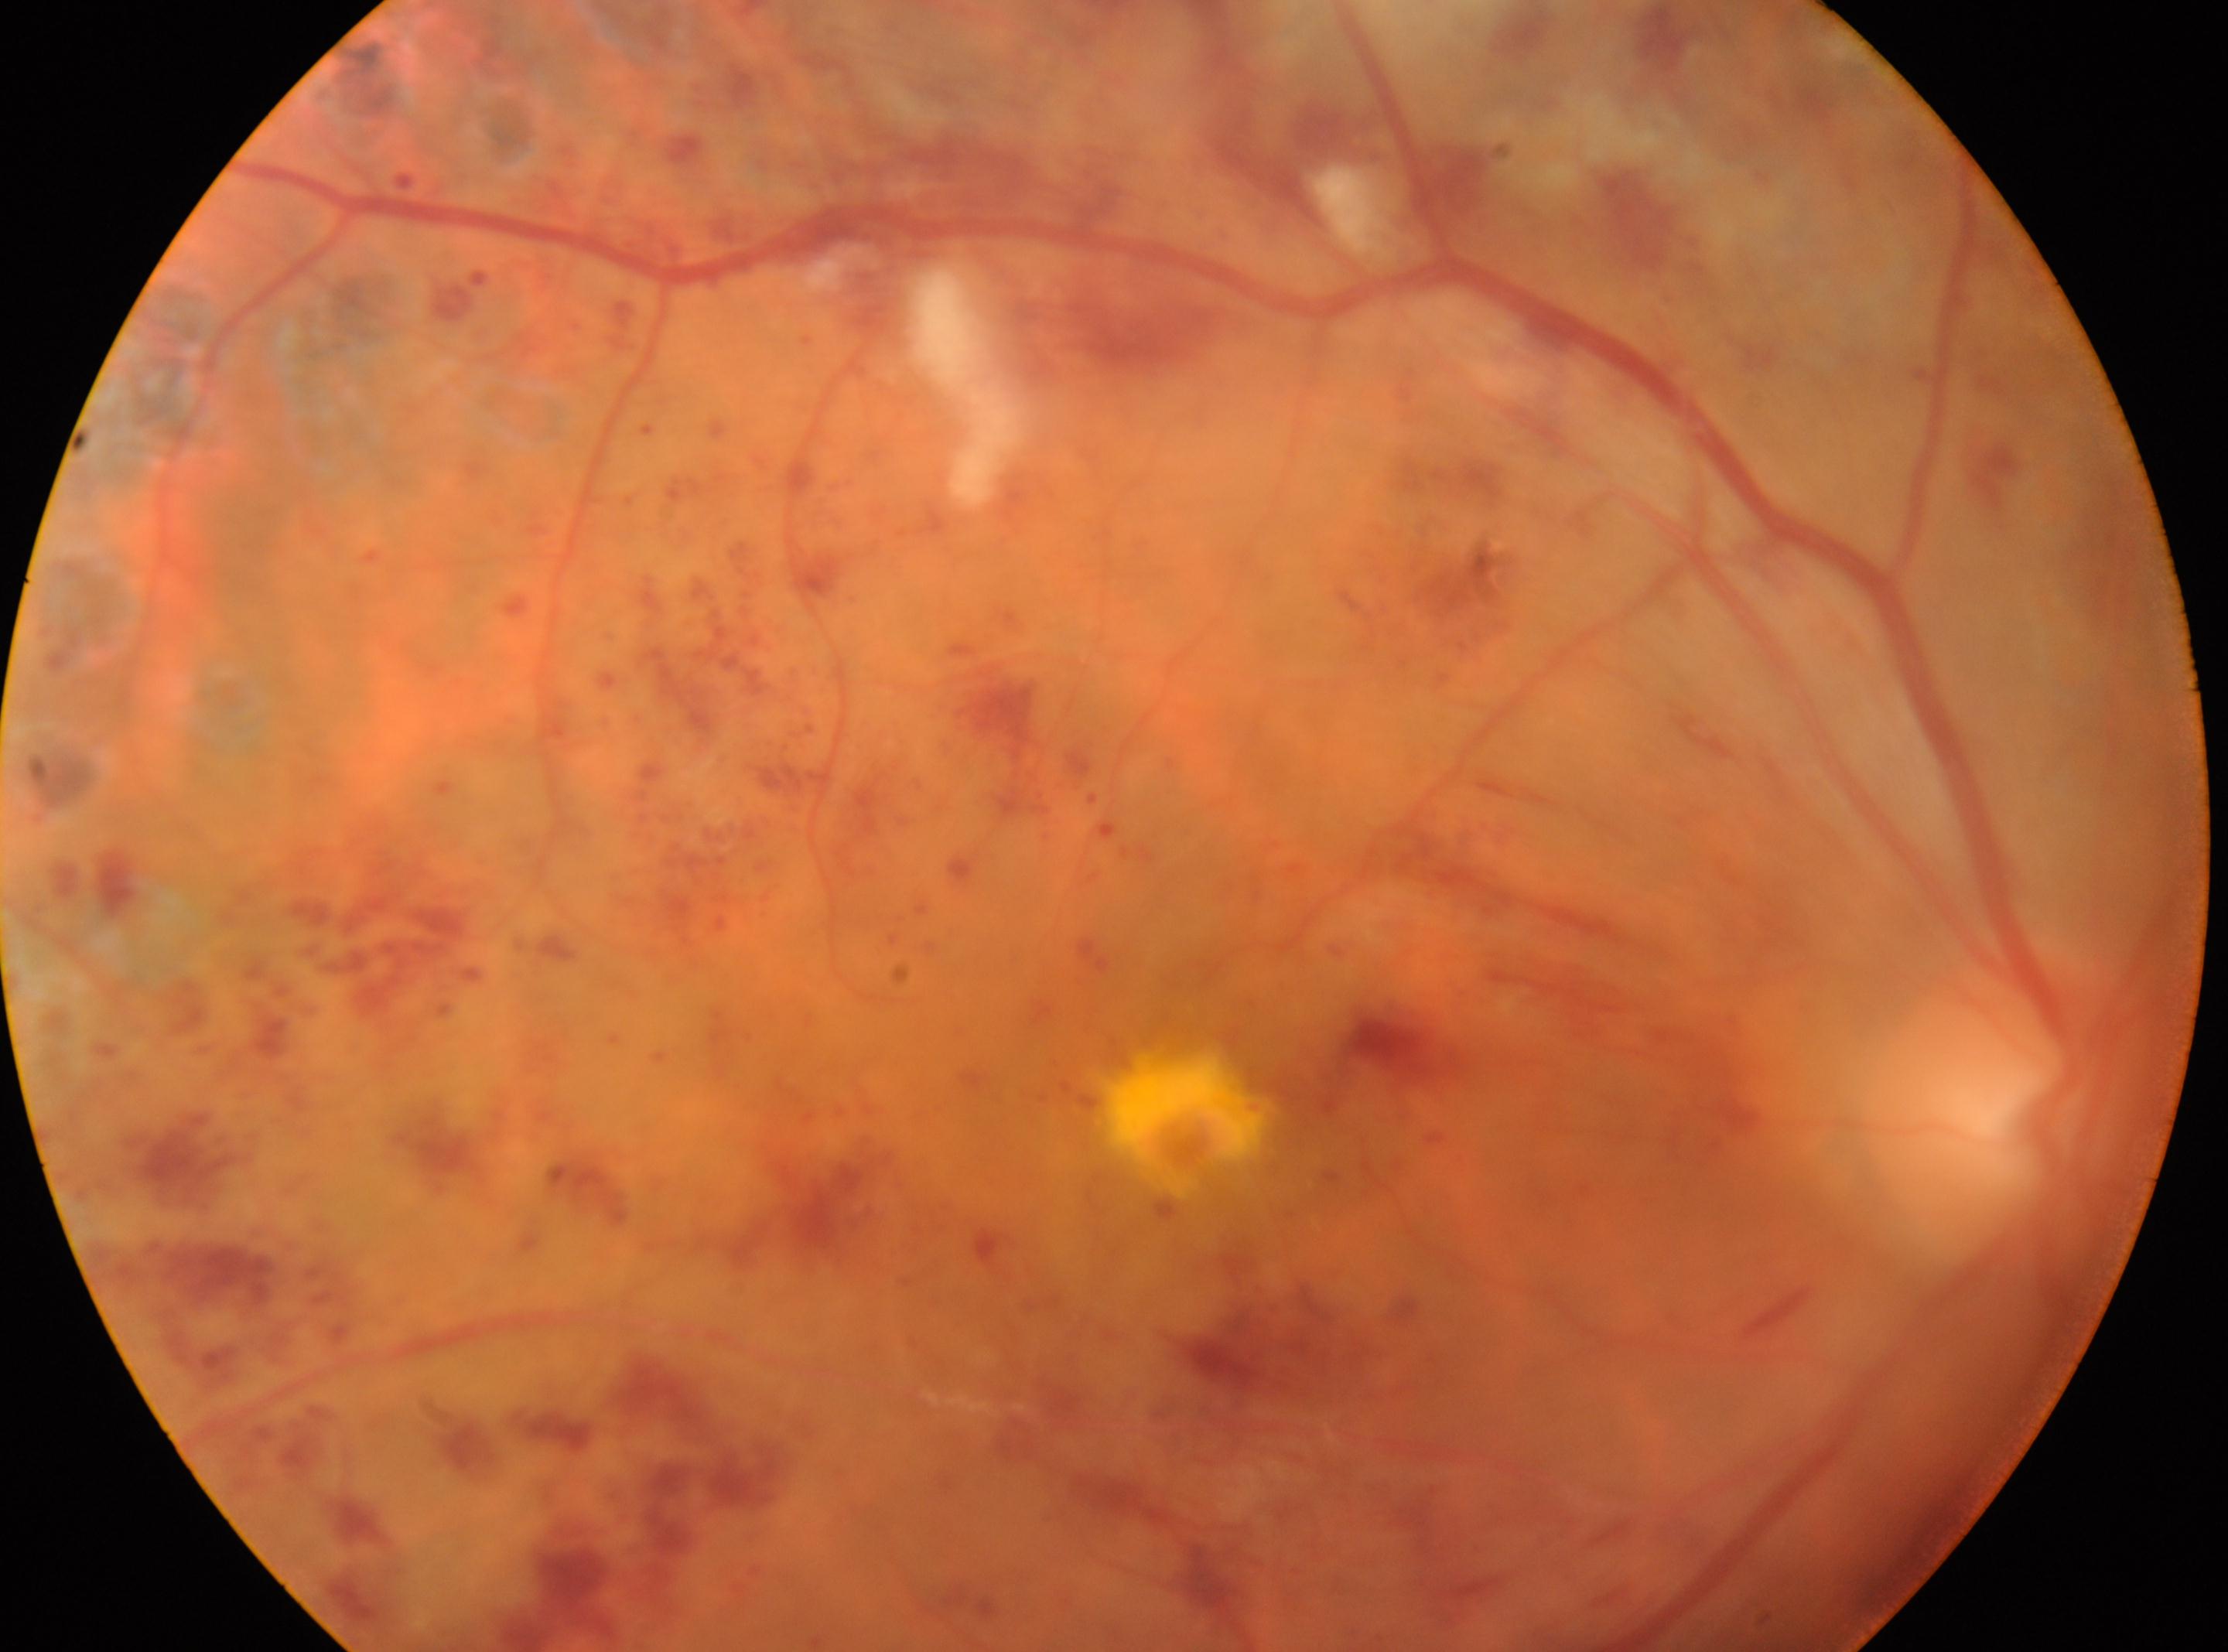 Annotations:
• DR grade · post-photocoagulation DR, underlying severity grade 3 (severe NPDR)
• macula center · 1185, 1138
• optic disc · 2001, 1102
• laterality · oculus dexter